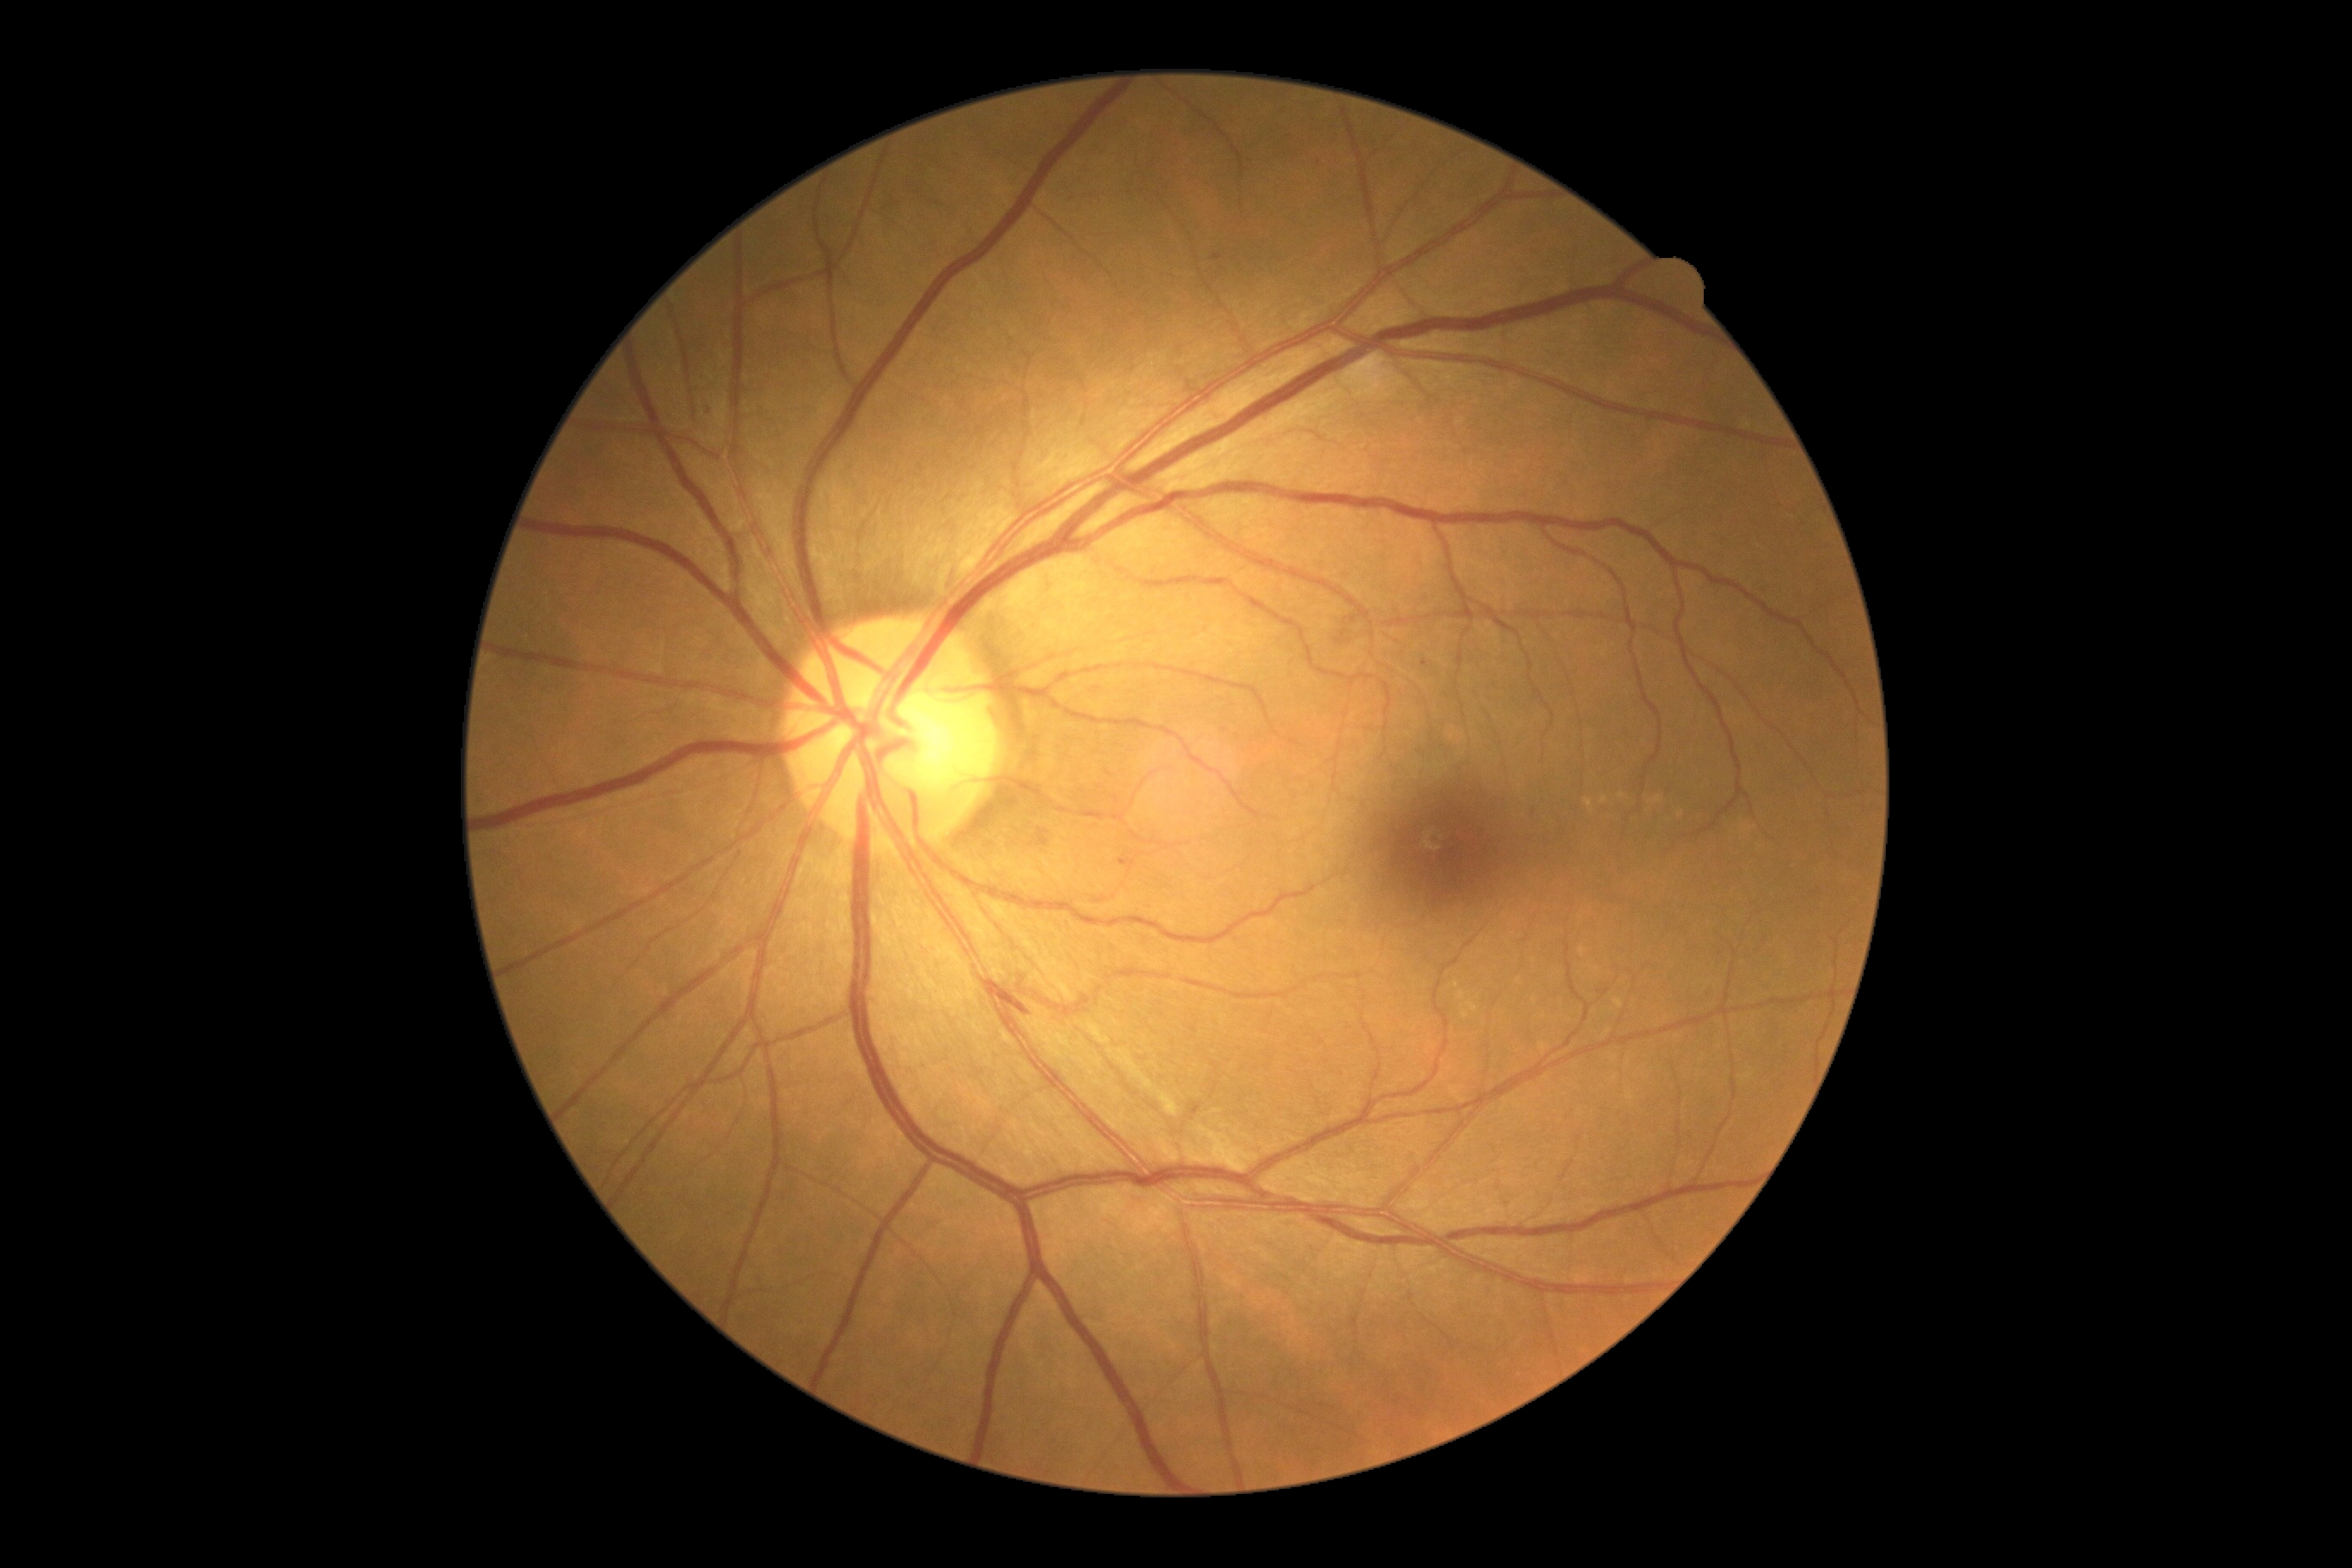 DR grade is moderate NPDR (2). The retinopathy is classified as non-proliferative diabetic retinopathy.